Color fundus photograph: 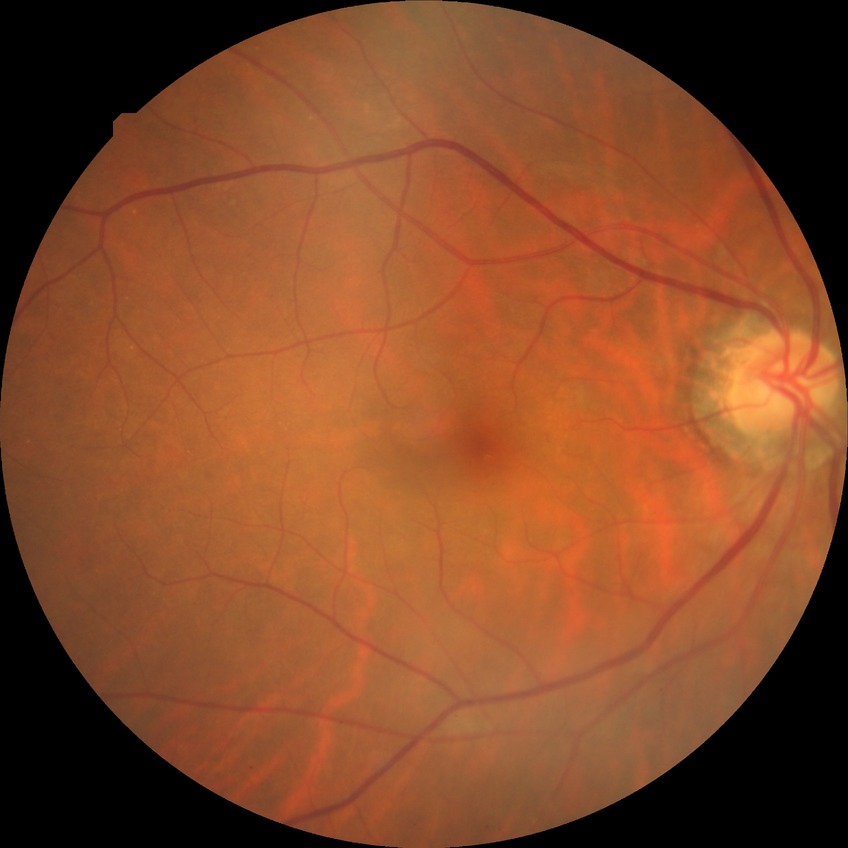
Modified Davis grading: simple diabetic retinopathy.